Central corneal thickness 587 µm. Refraction: +3 -1.75 × 5°. Age 71. Axial length: 23.36 mm.
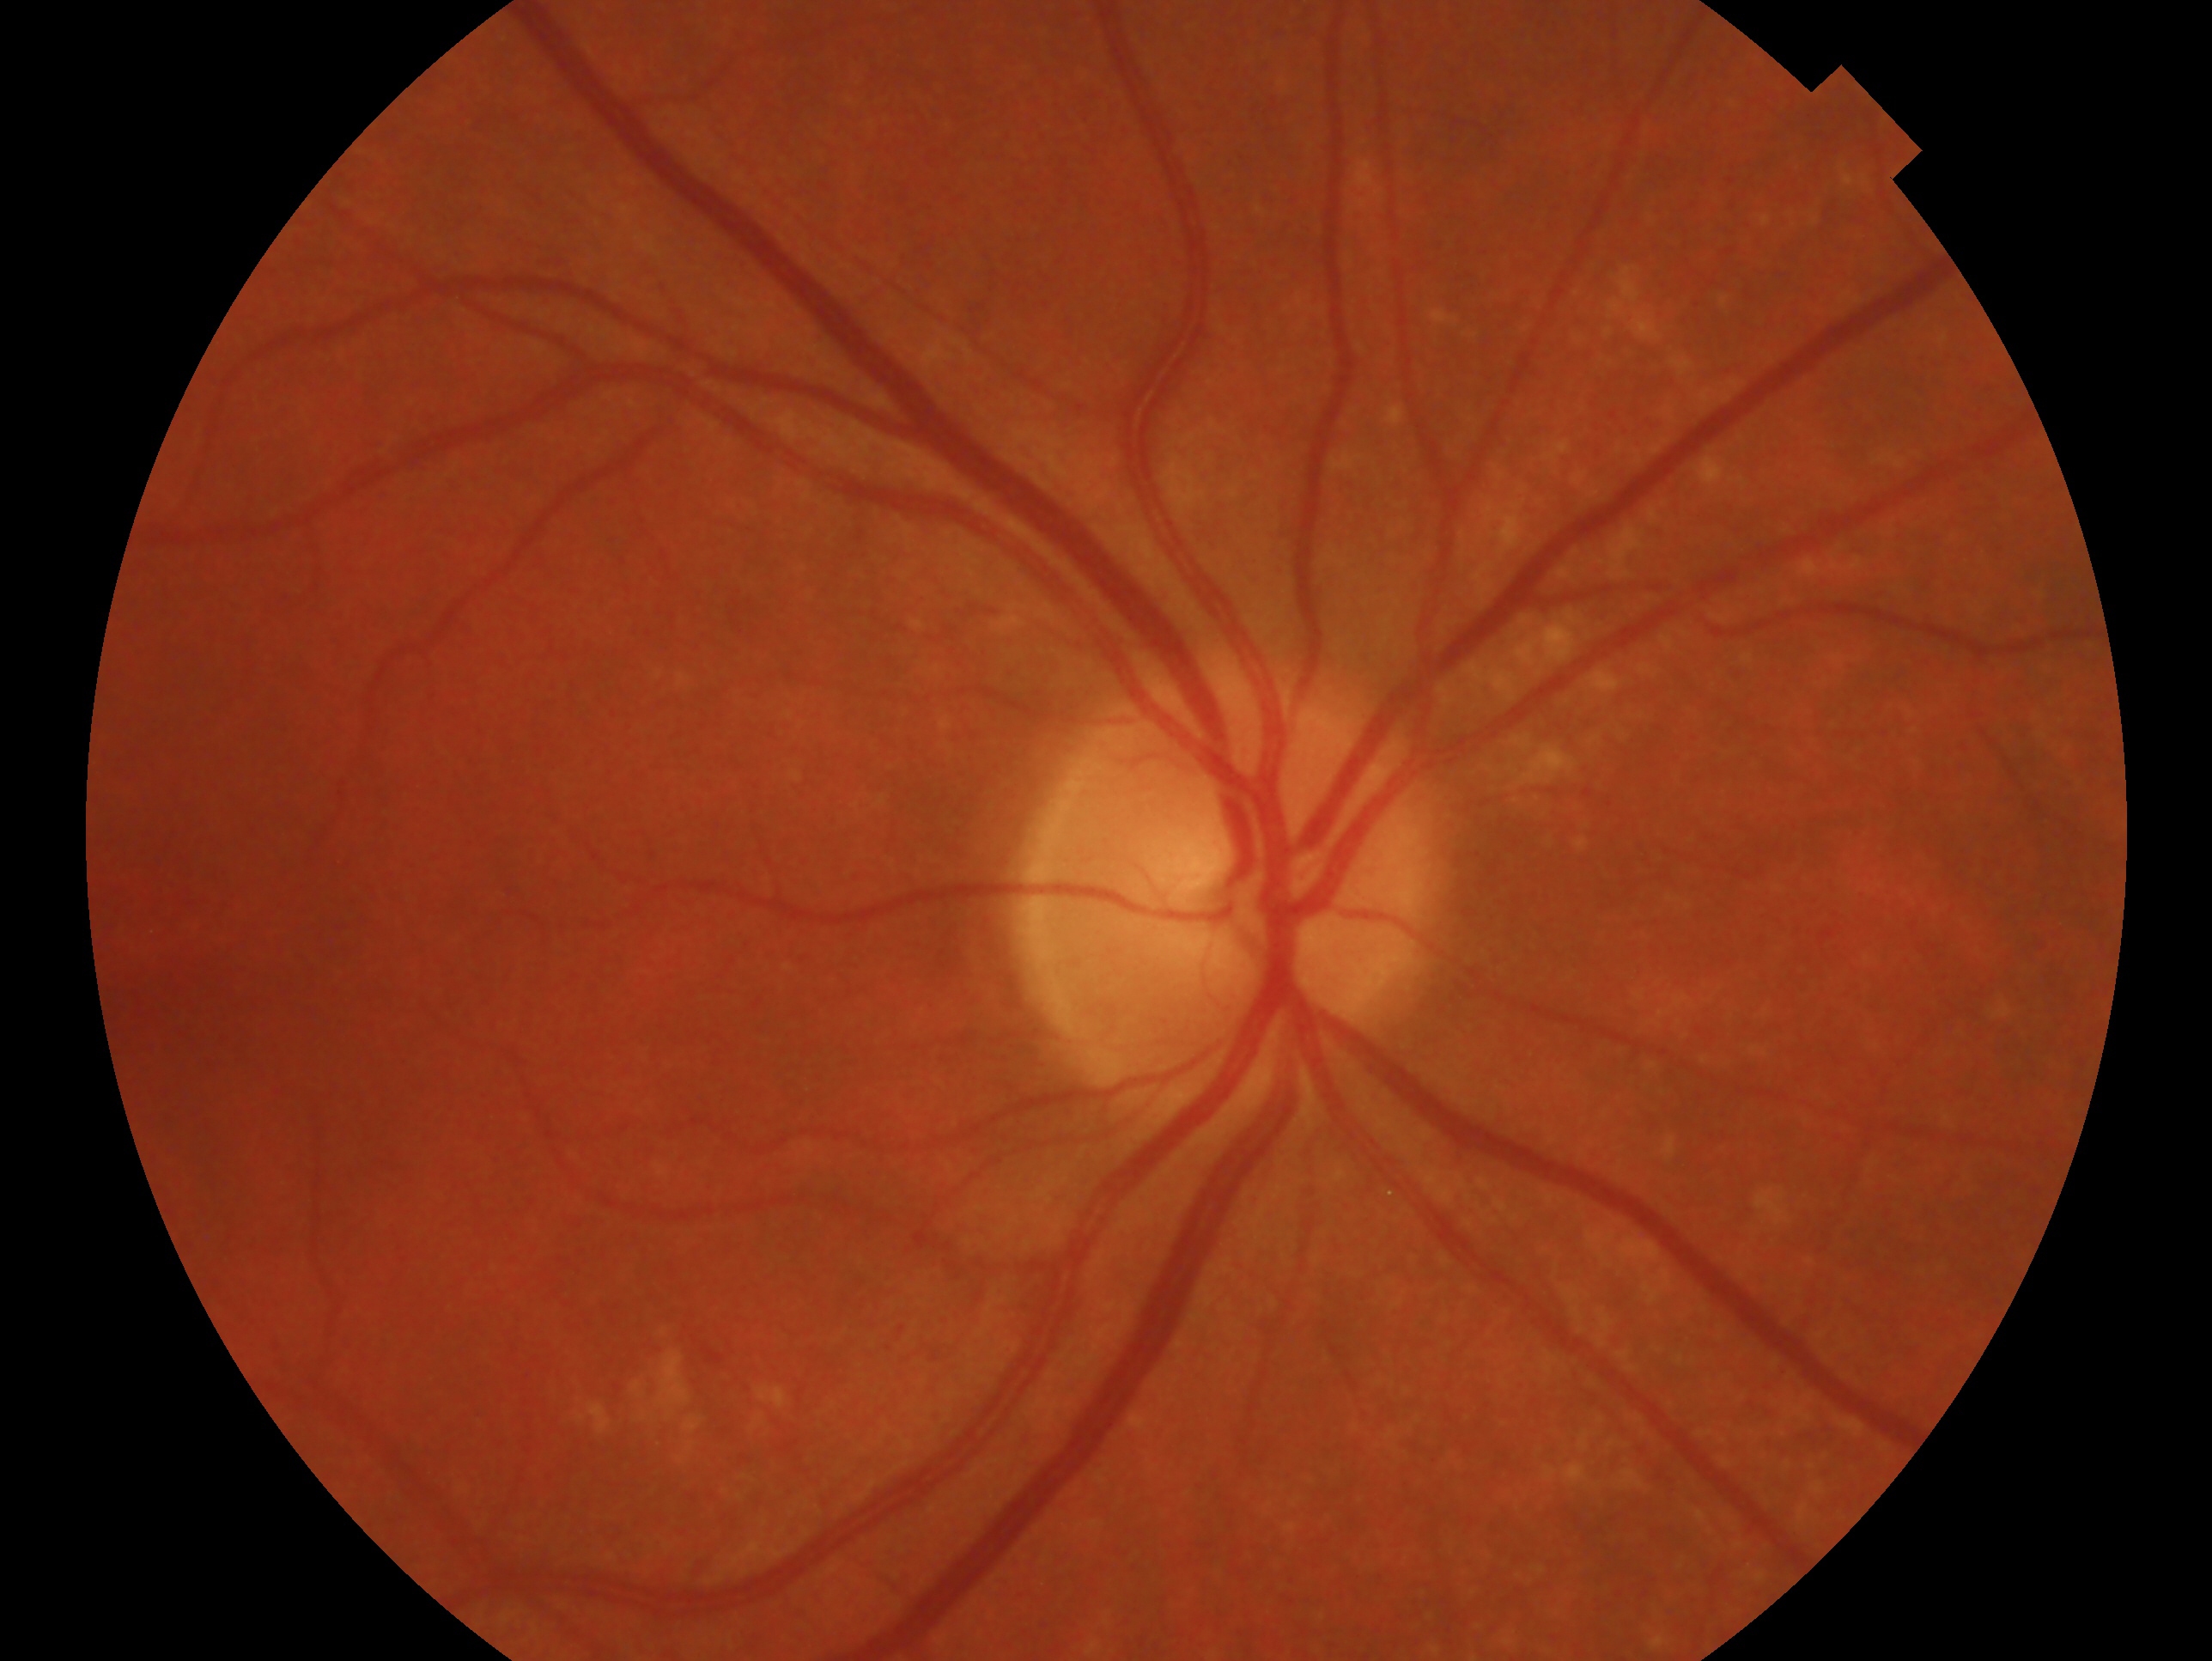

Imaged eye: OD. Diagnosis: negative for glaucoma.